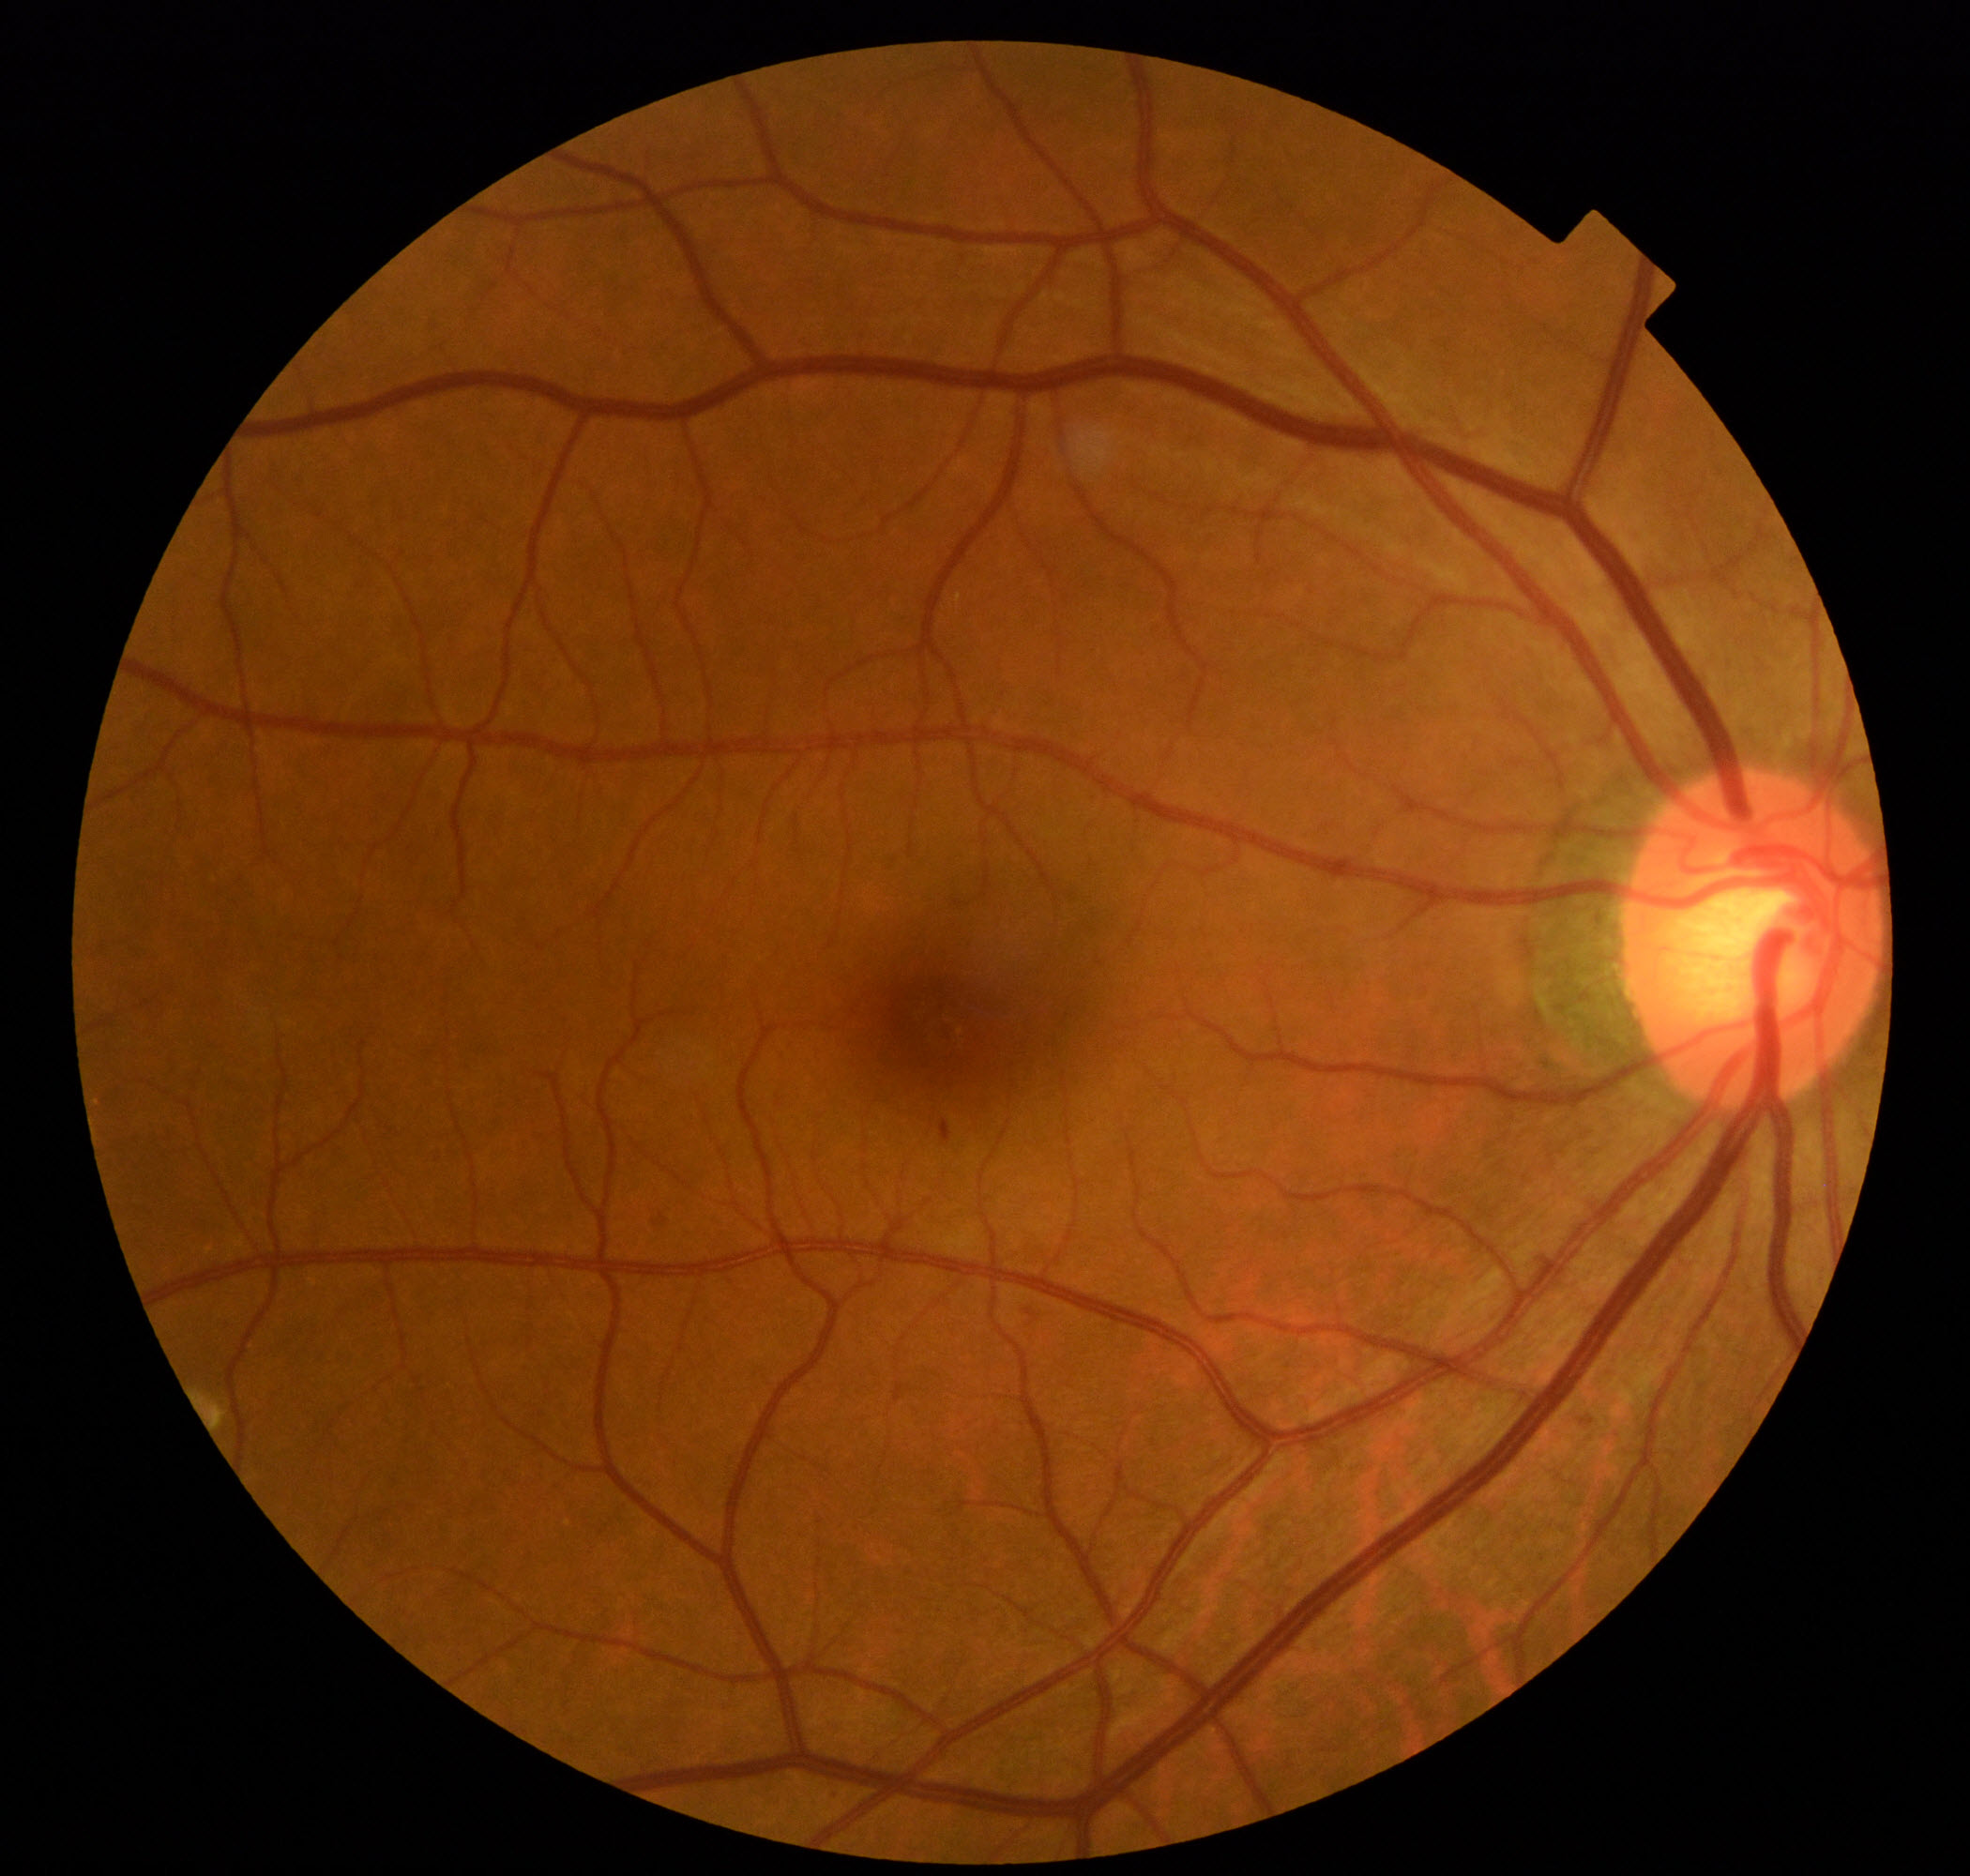 Diagnosis: mild non-proliferative diabetic retinopathy.